Color fundus photograph; 1932x1932:
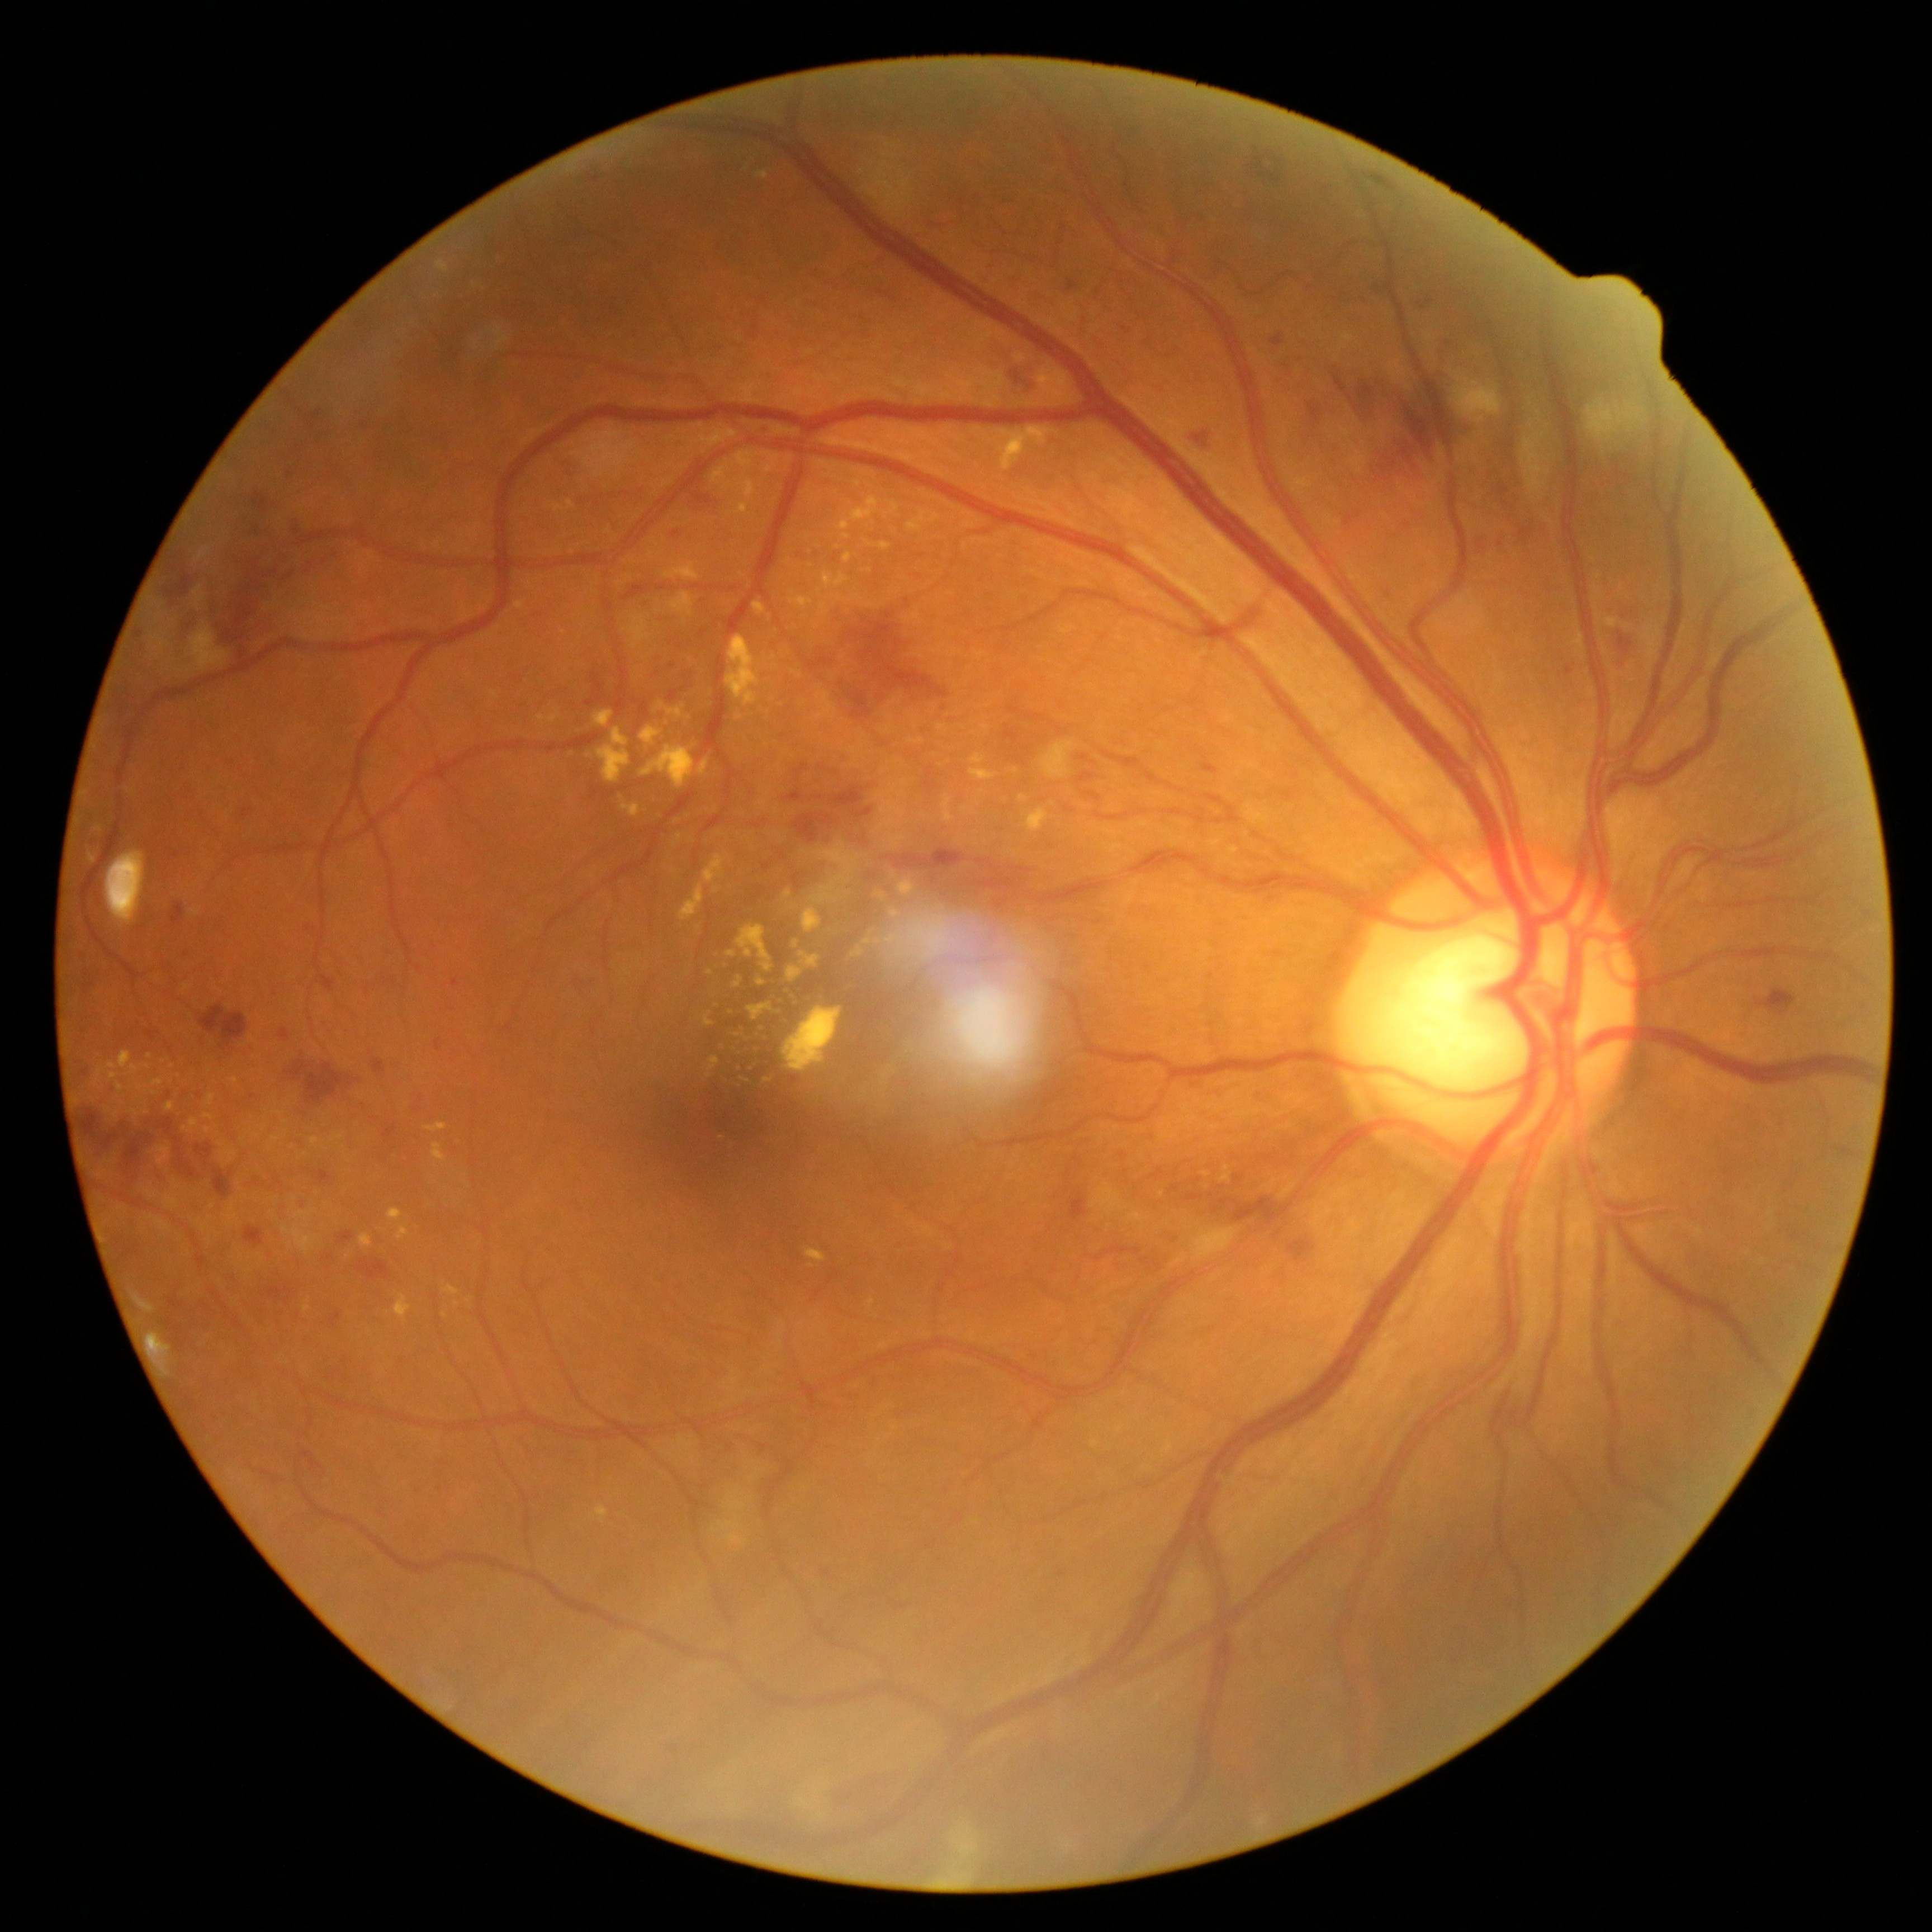

Diabetic retinopathy grade is severe NPDR (3). Hard exudates include those at bbox(727, 634, 763, 707); bbox(906, 510, 941, 533); bbox(1219, 1166, 1230, 1183); bbox(1020, 795, 1029, 804); bbox(247, 1130, 259, 1139); bbox(749, 1003, 773, 1021); bbox(438, 261, 450, 273); bbox(943, 795, 953, 822); bbox(937, 725, 948, 734); bbox(846, 595, 861, 604); bbox(793, 941, 799, 950). Small hard exudates near point(726, 966); point(697, 747); point(738, 717); point(468, 1301); point(766, 1042); point(541, 719); point(795, 997).